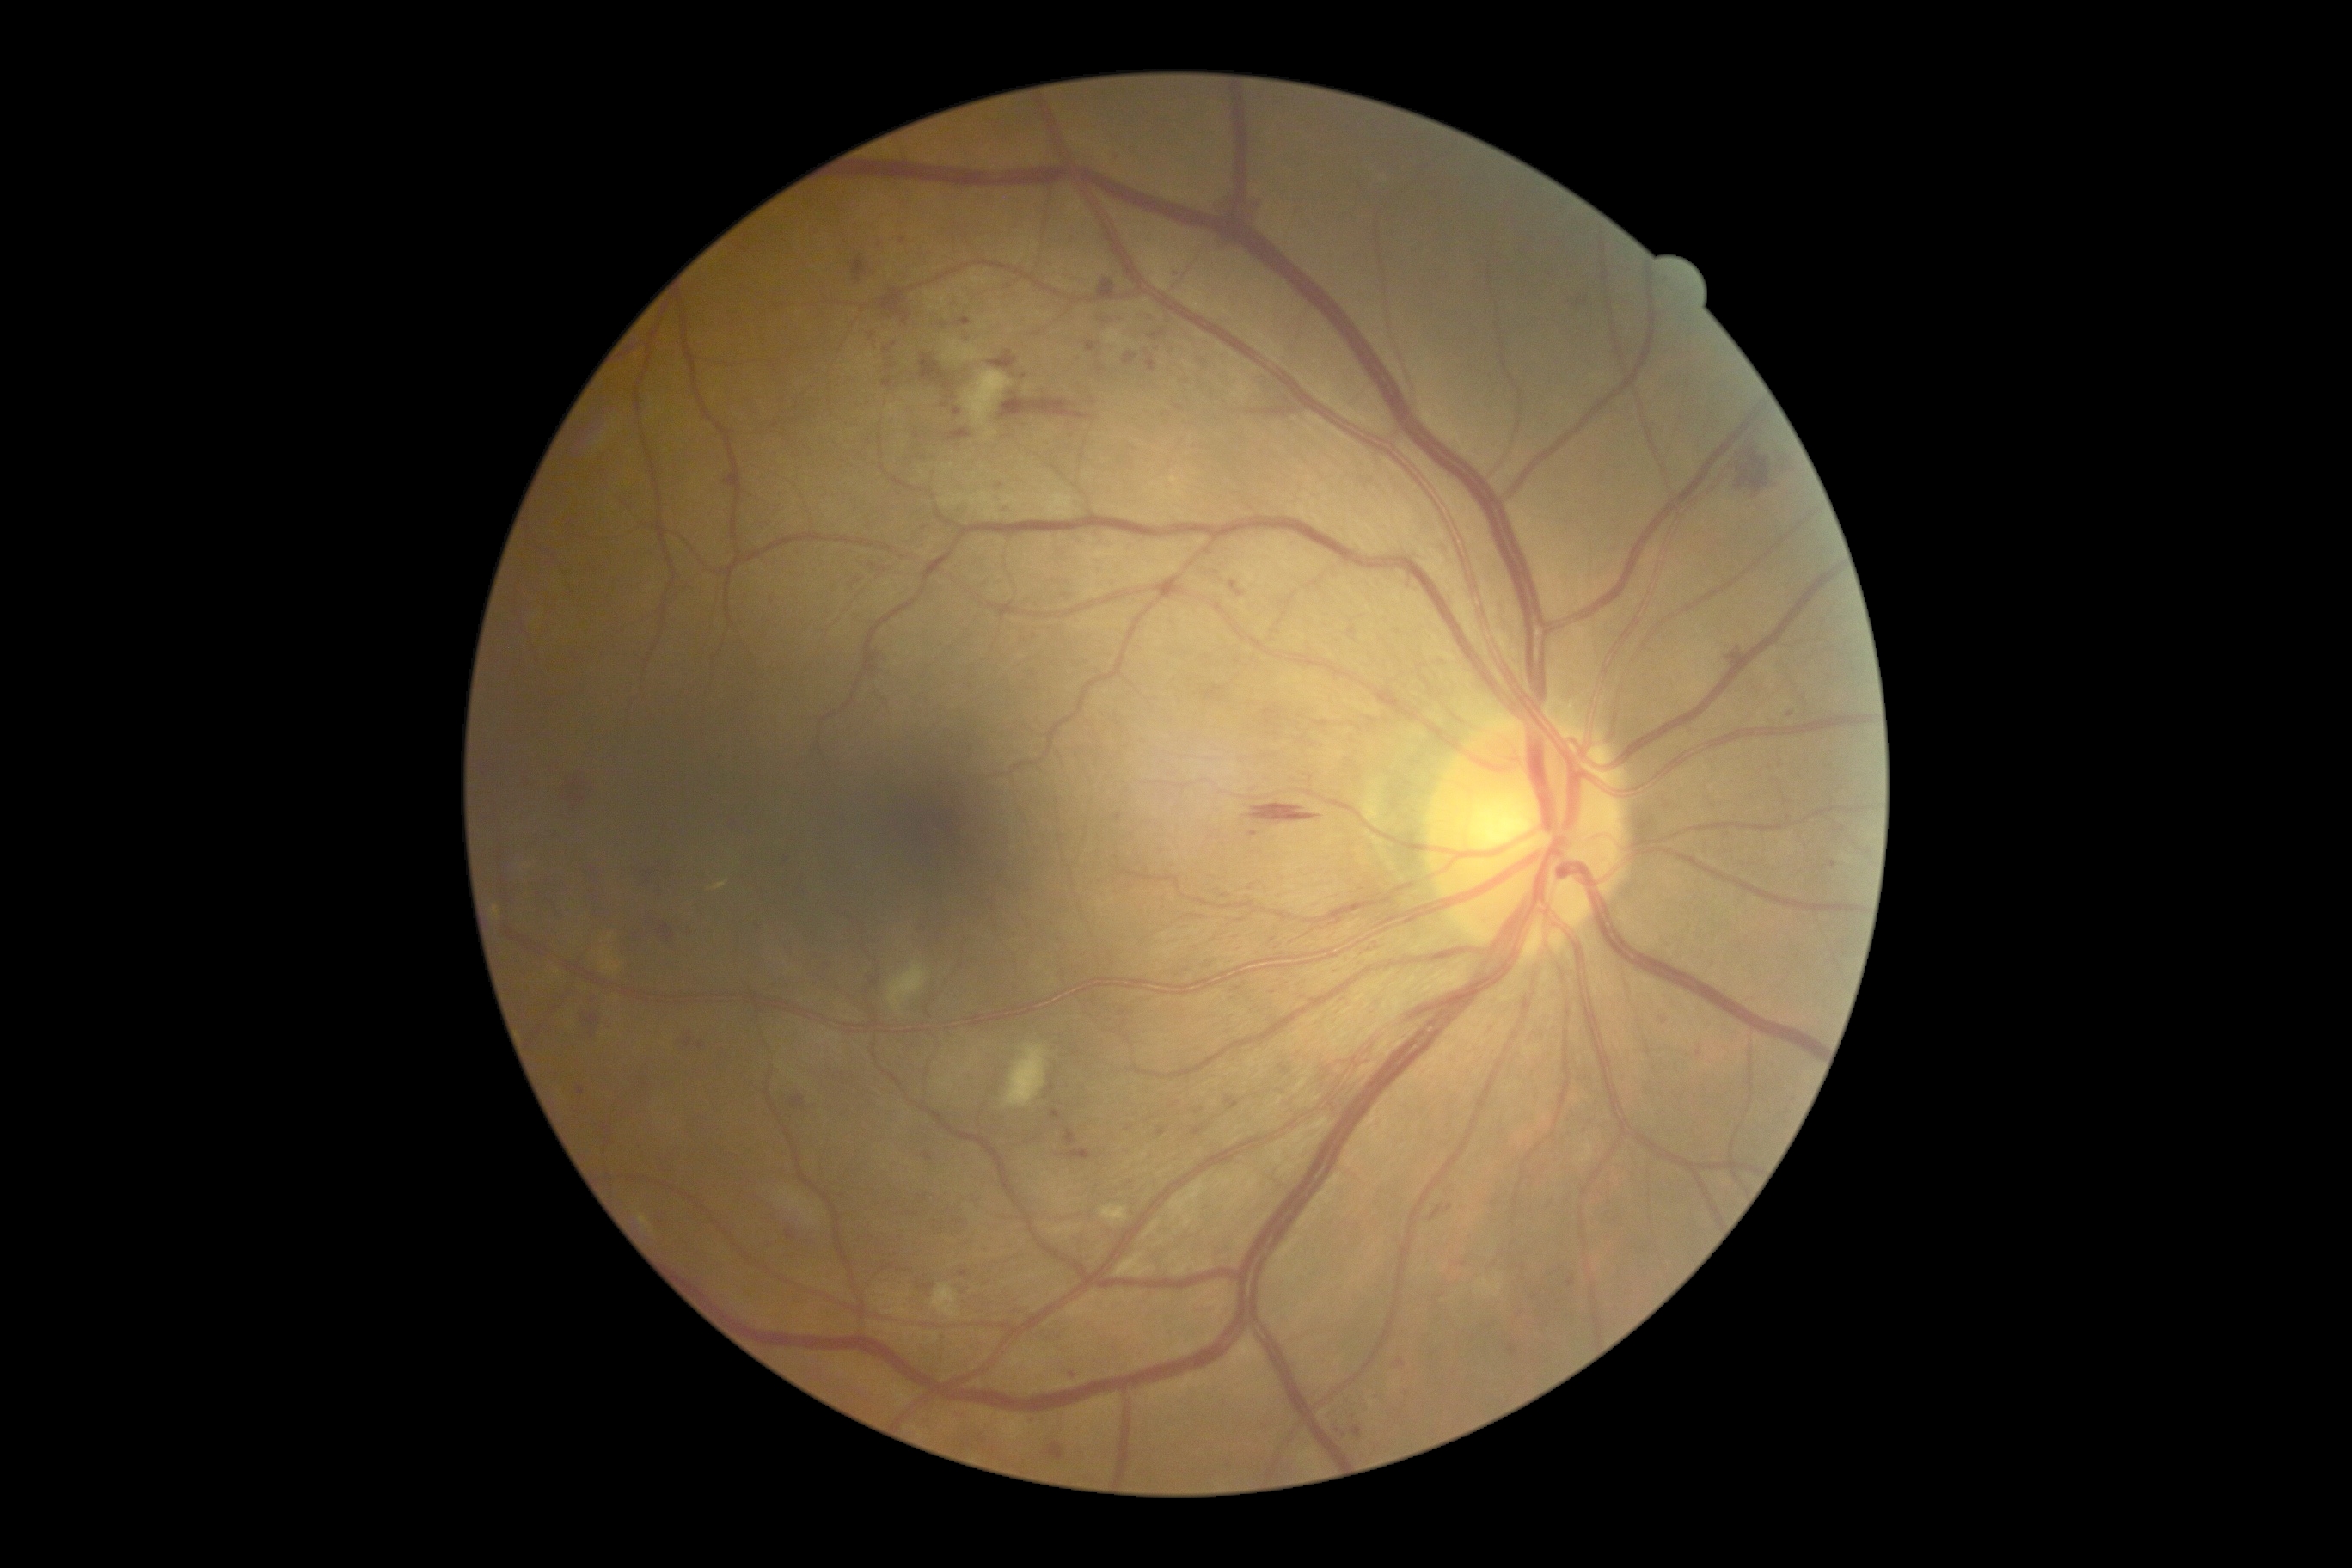
DR stage: grade 2